CFP; 45° FOV; 2212 by 1672 pixels: 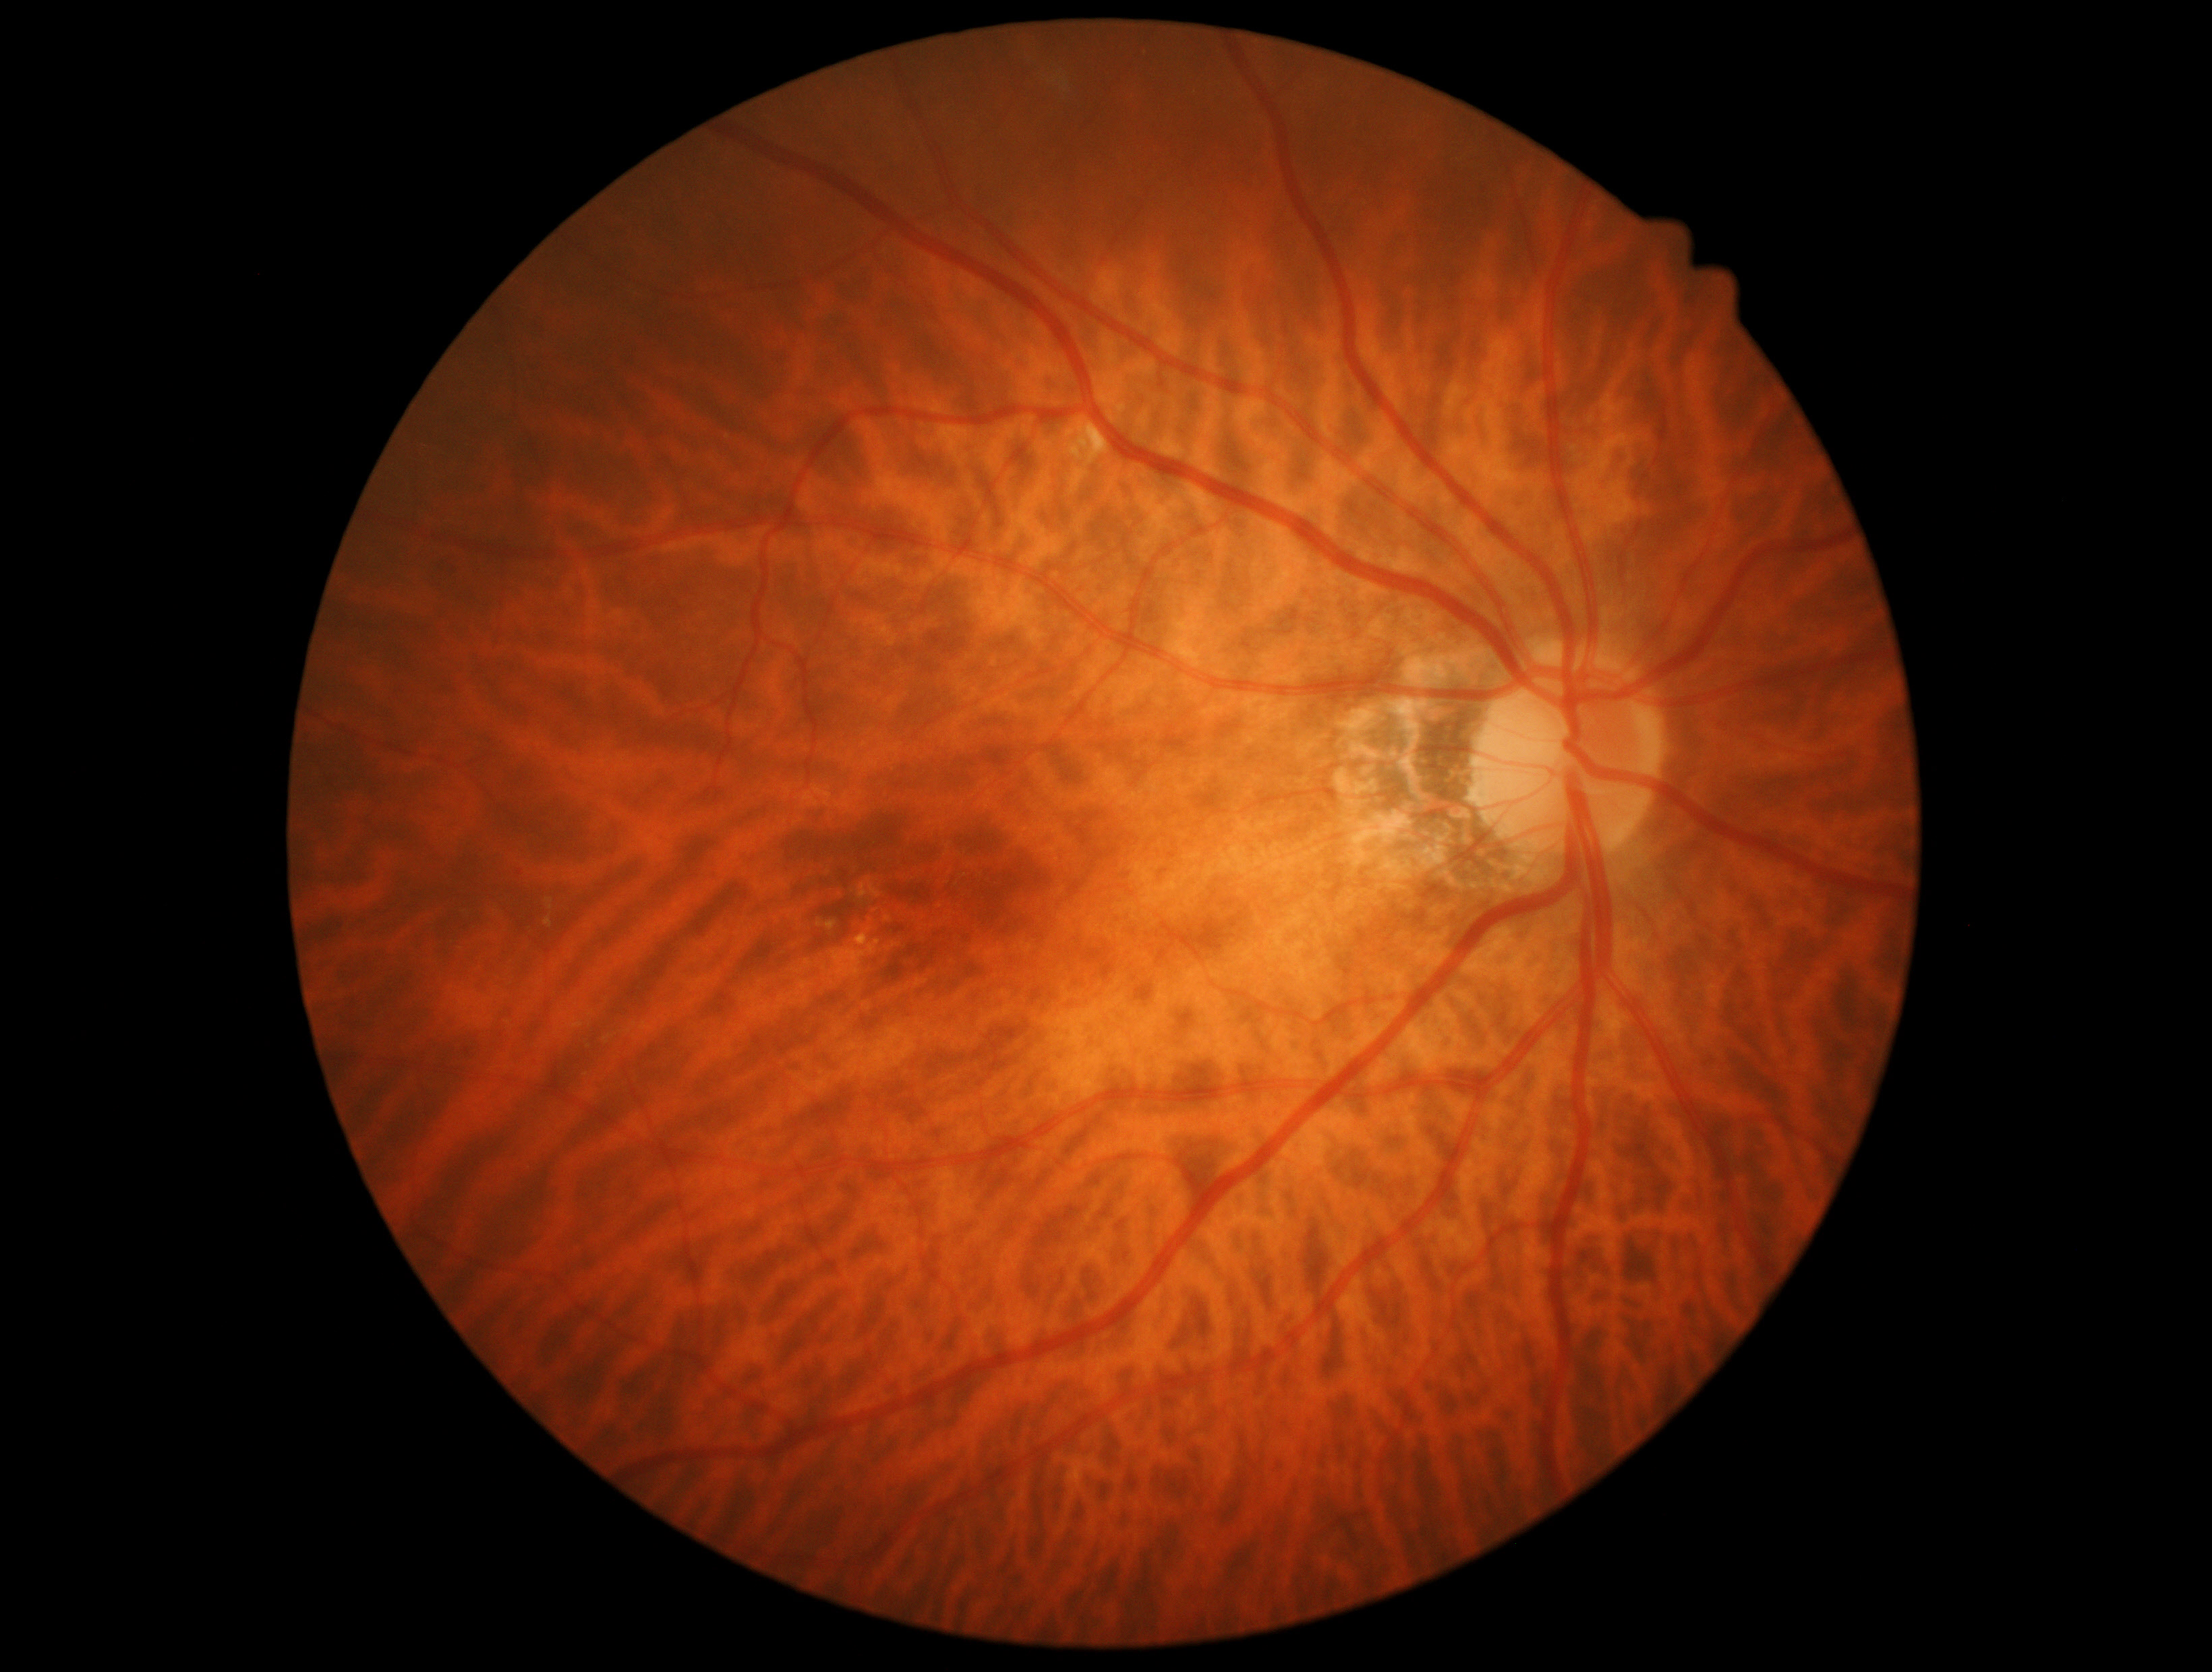

Retinopathy is 2.